1725 by 1721 pixels, 45° field of view.
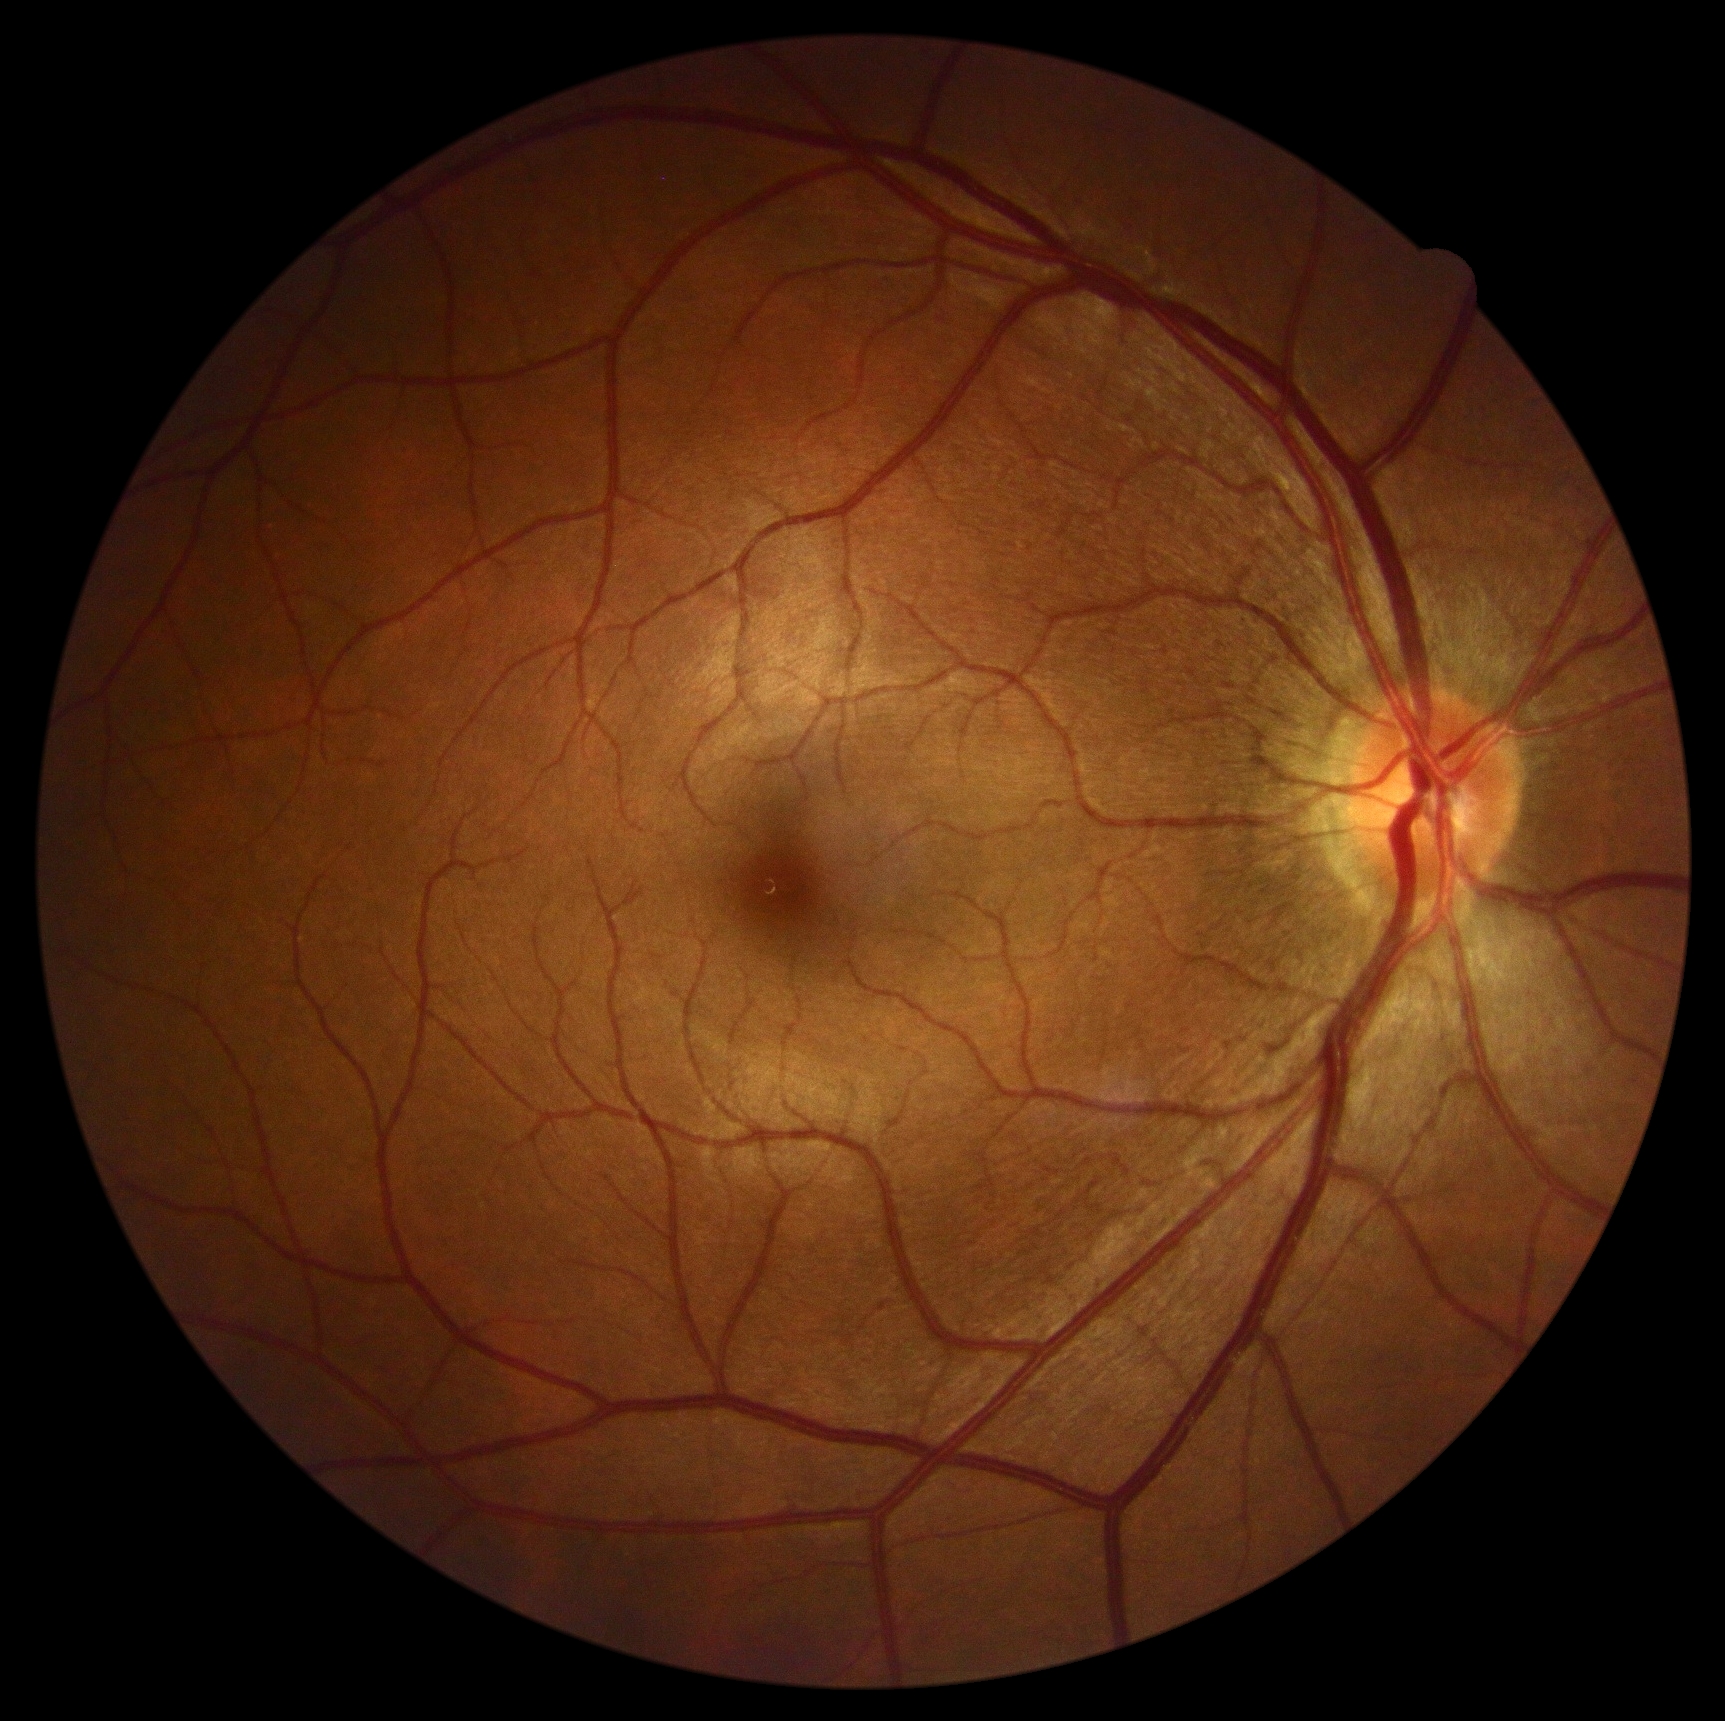
DR grade = 0 (no apparent retinopathy).